240 by 240 pixels: 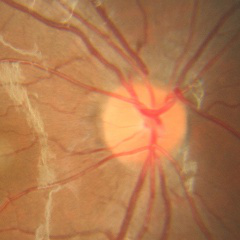

Glaucoma diagnosis: no signs of glaucoma.